Graded on the modified Davis scale — 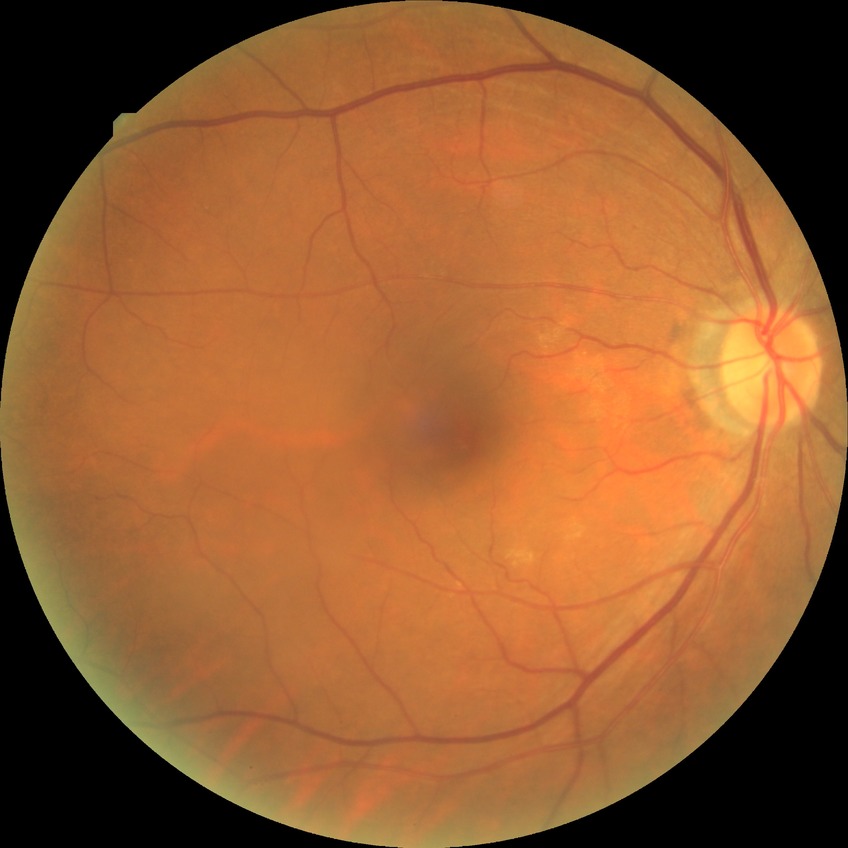
Diabetic retinopathy (DR) is NDR (no diabetic retinopathy).